CFP
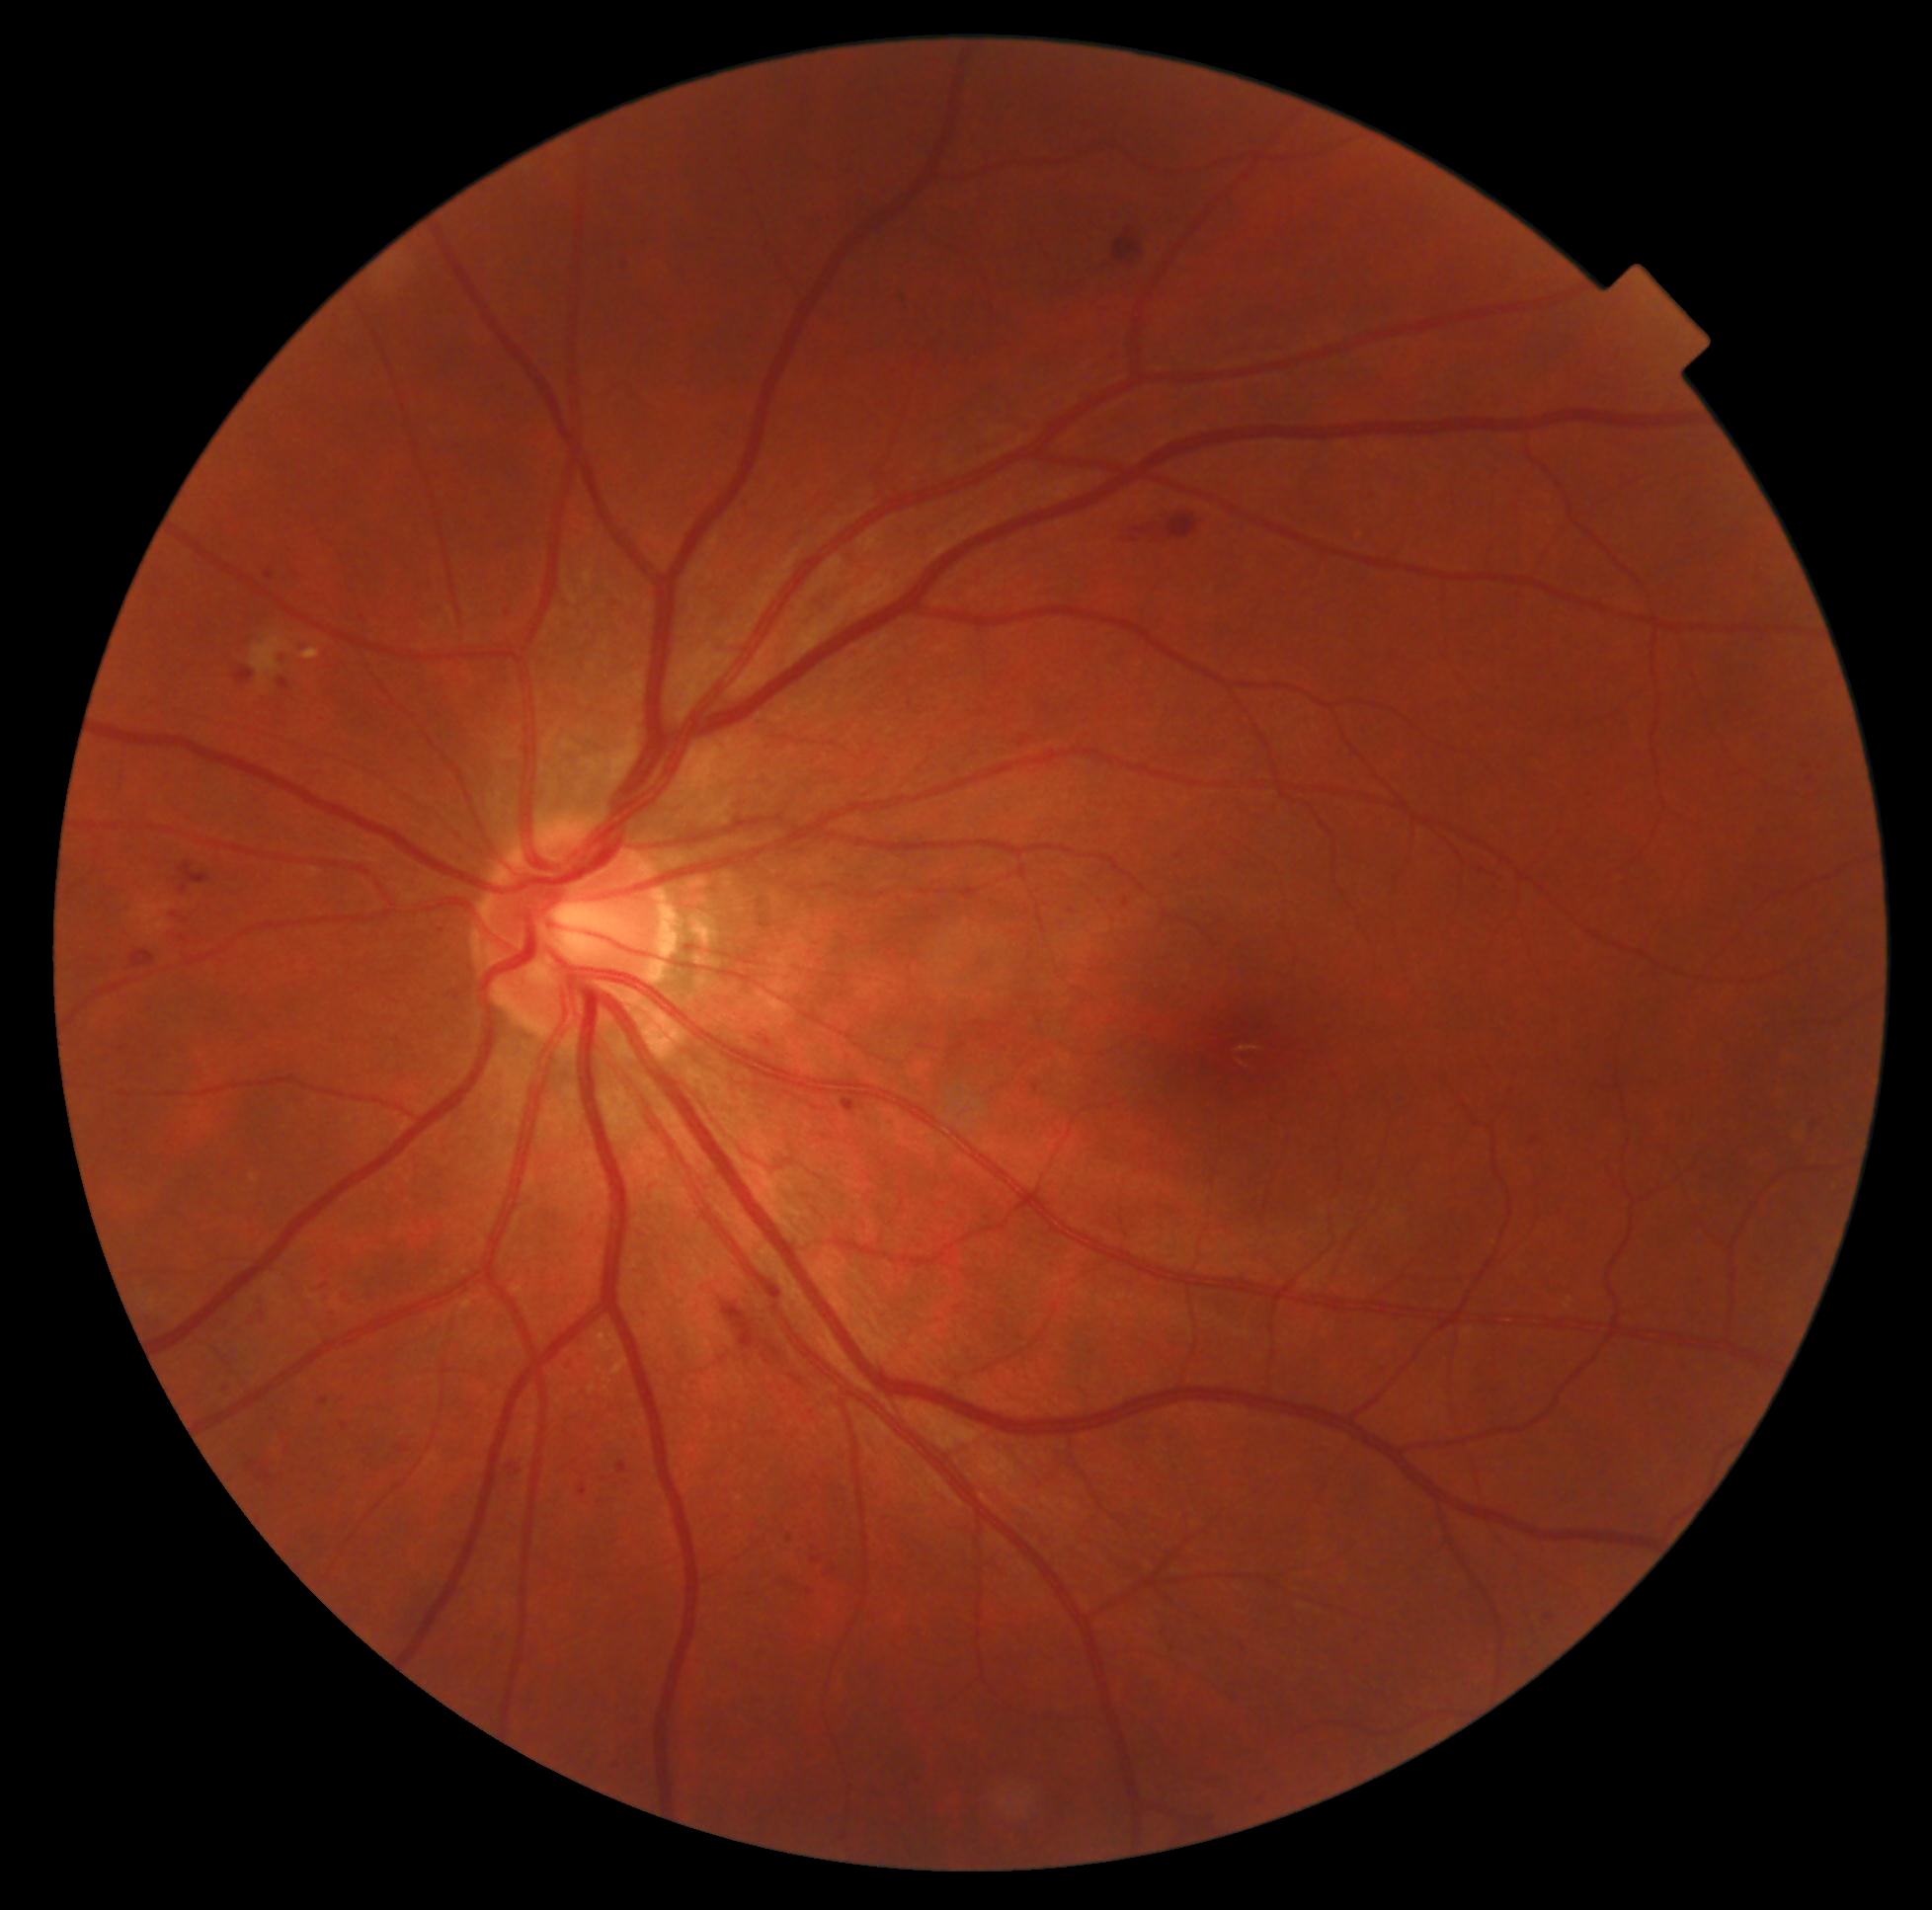 retinopathy=moderate NPDR (grade 2).